2048 x 1536 pixels; FOV: 45 degrees — 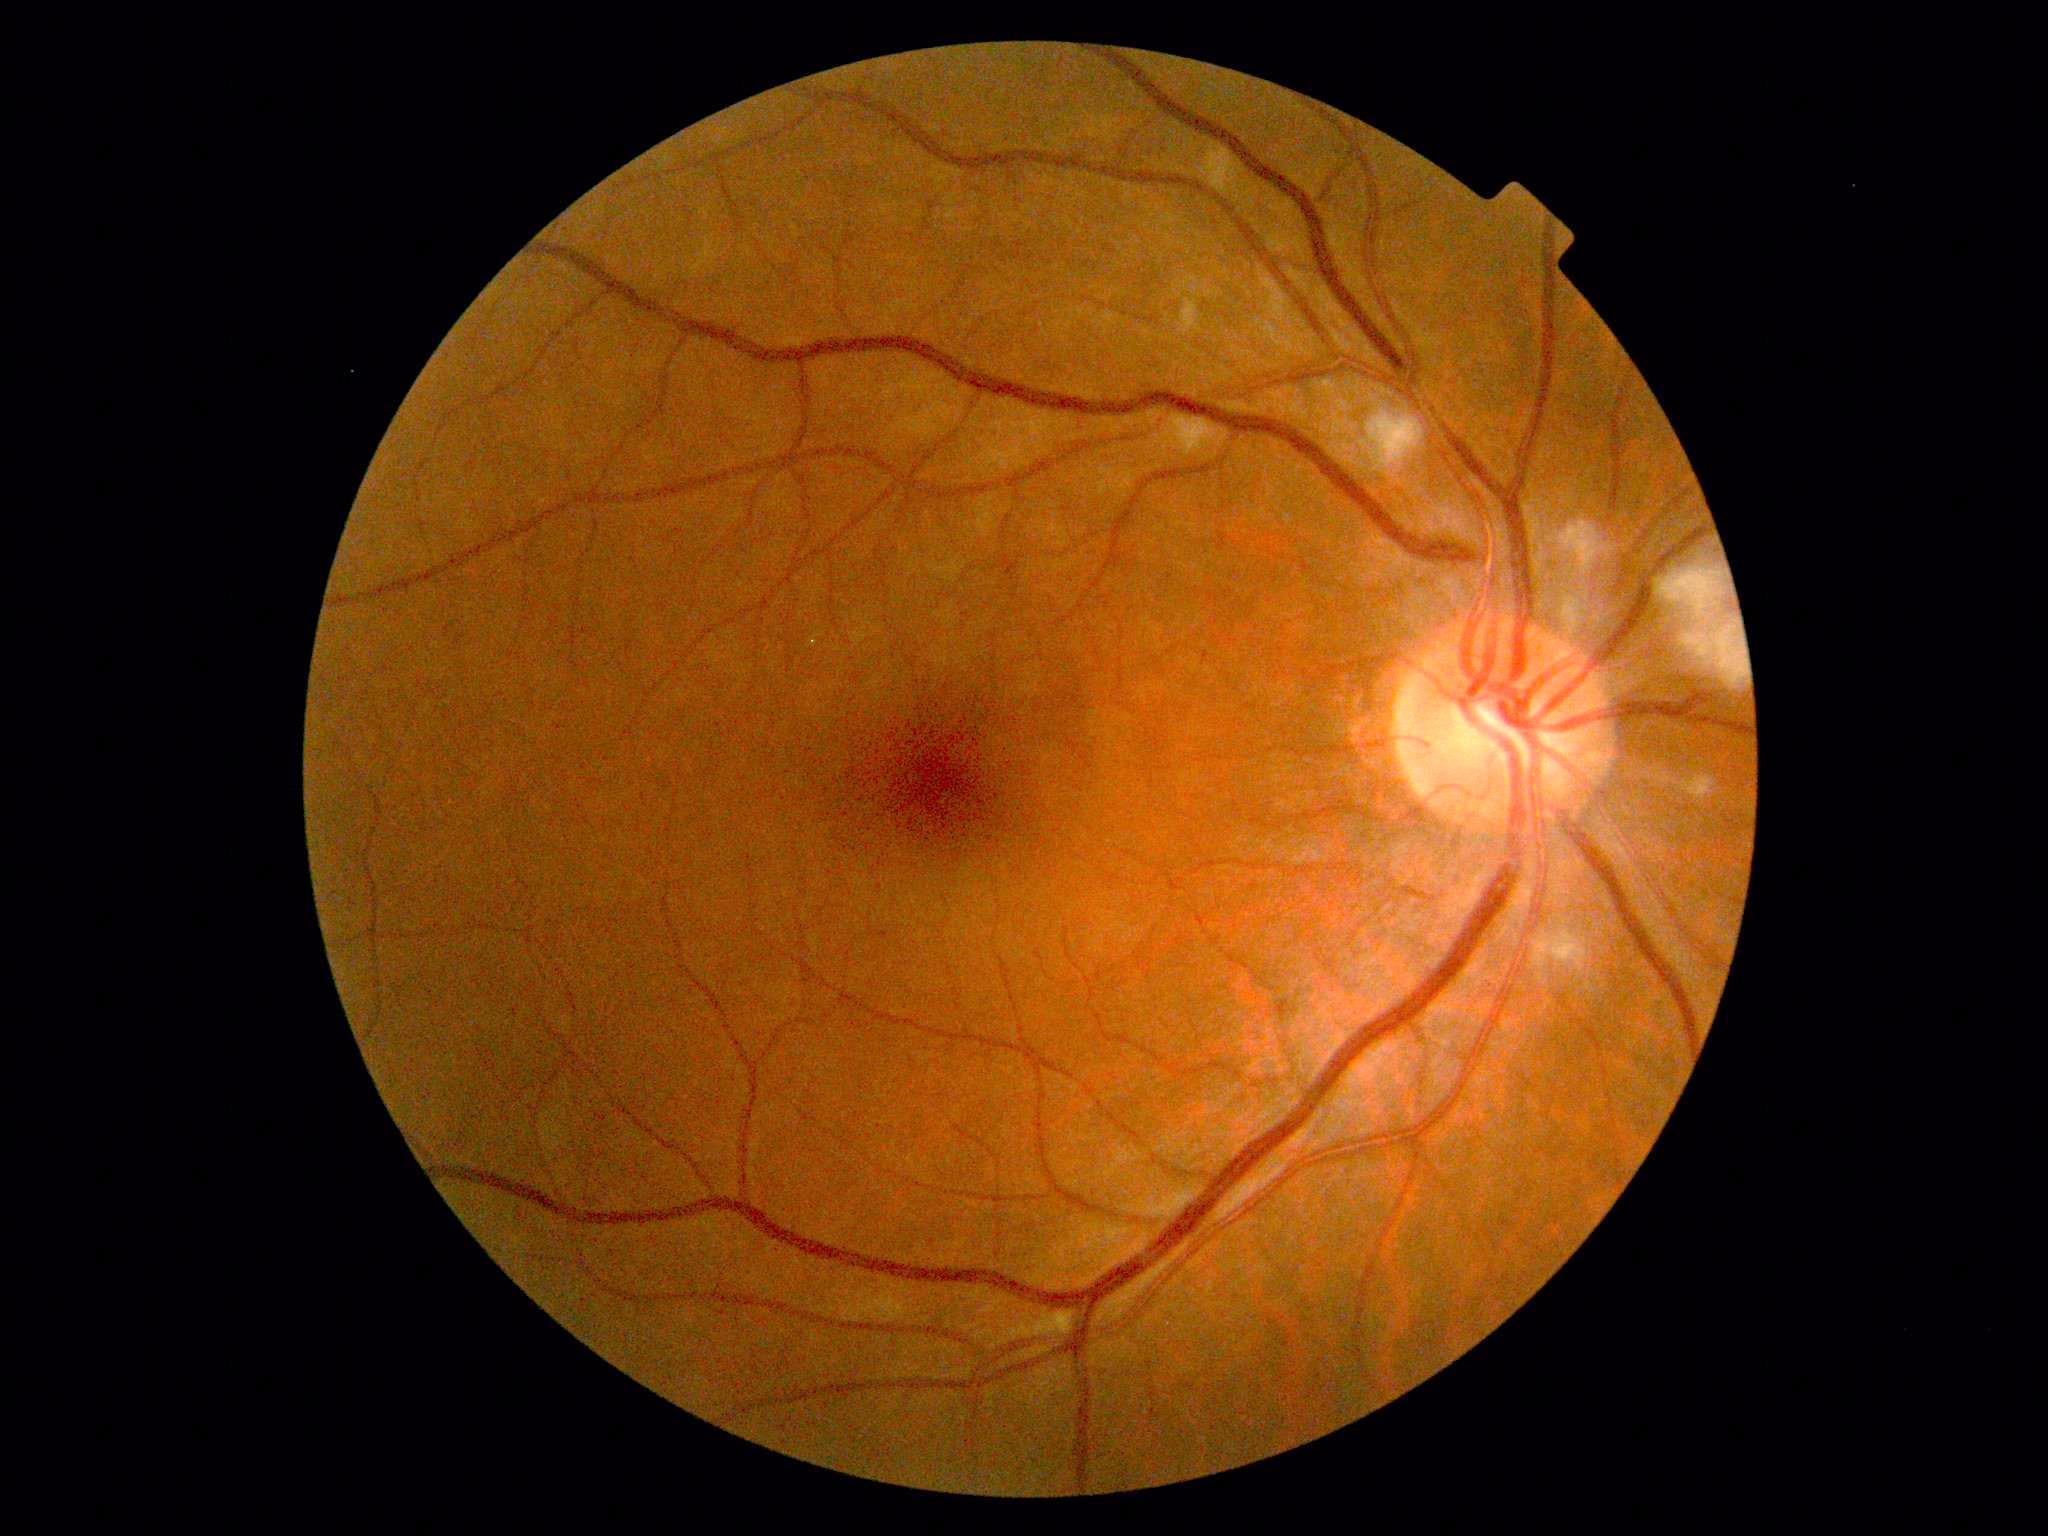

The retinopathy is classified as non-proliferative diabetic retinopathy. Retinopathy grade is 2.